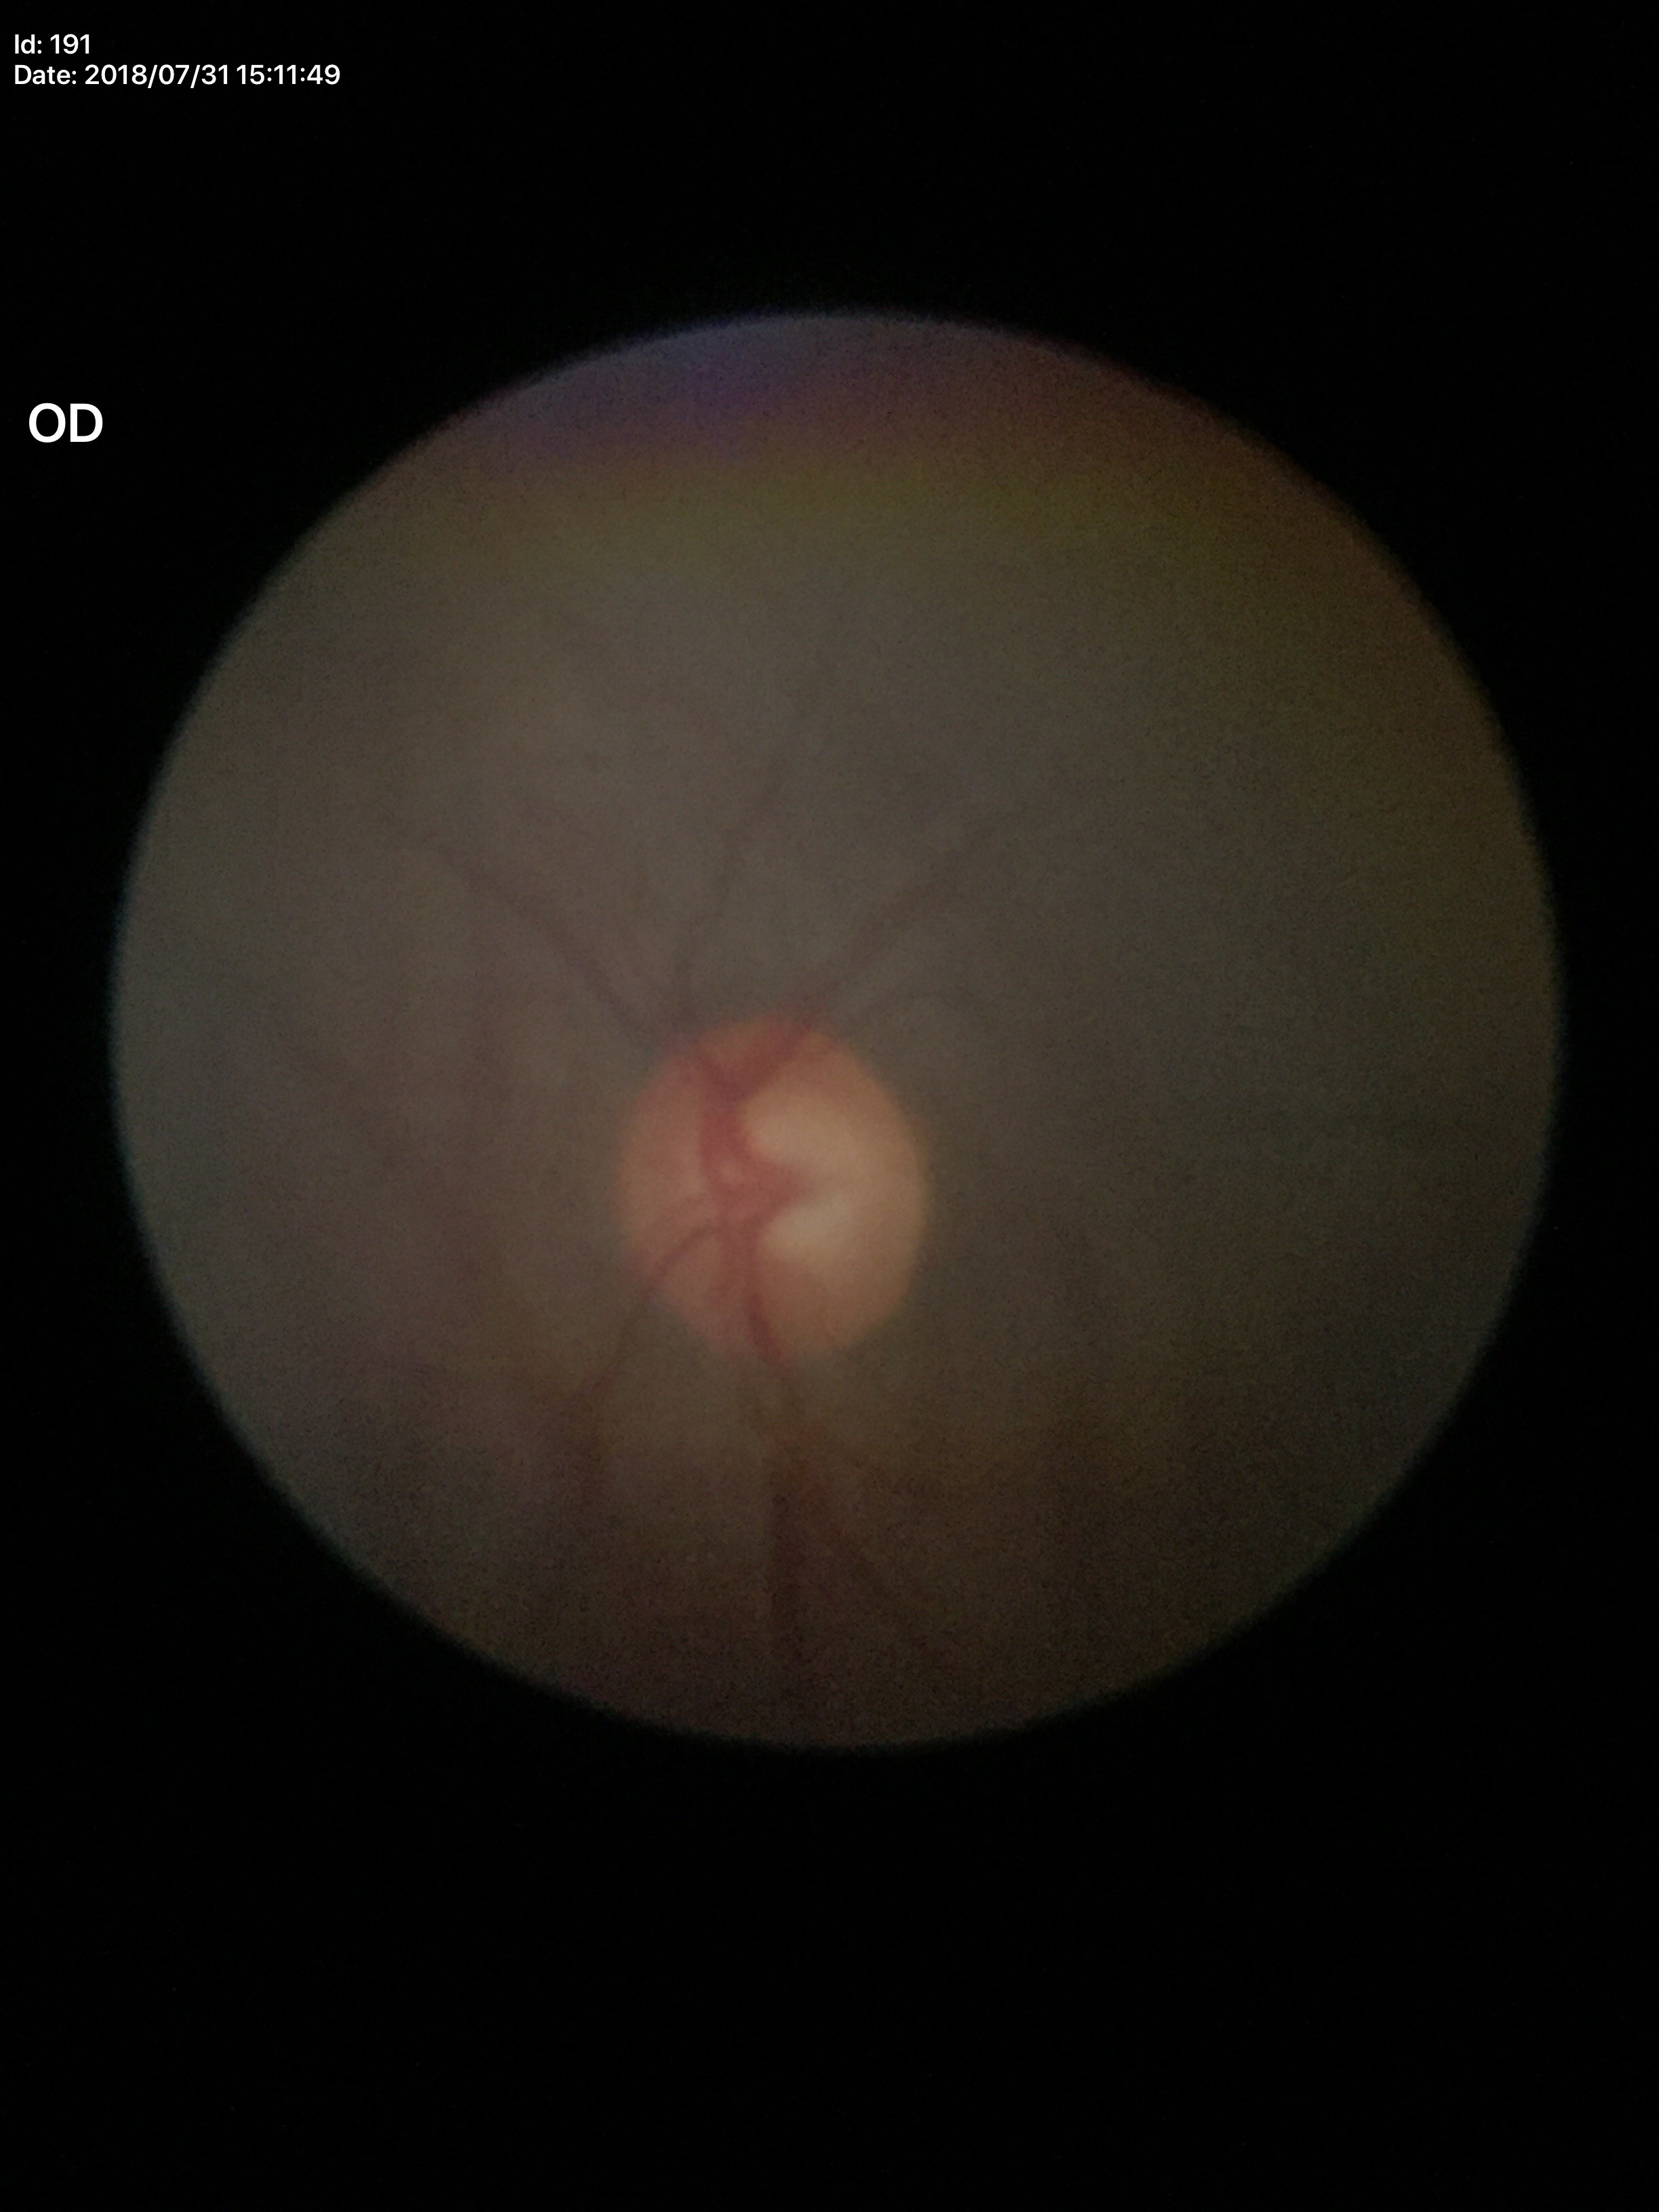

VCDR: 0.59; Glaucoma evaluation: no suspicious findings